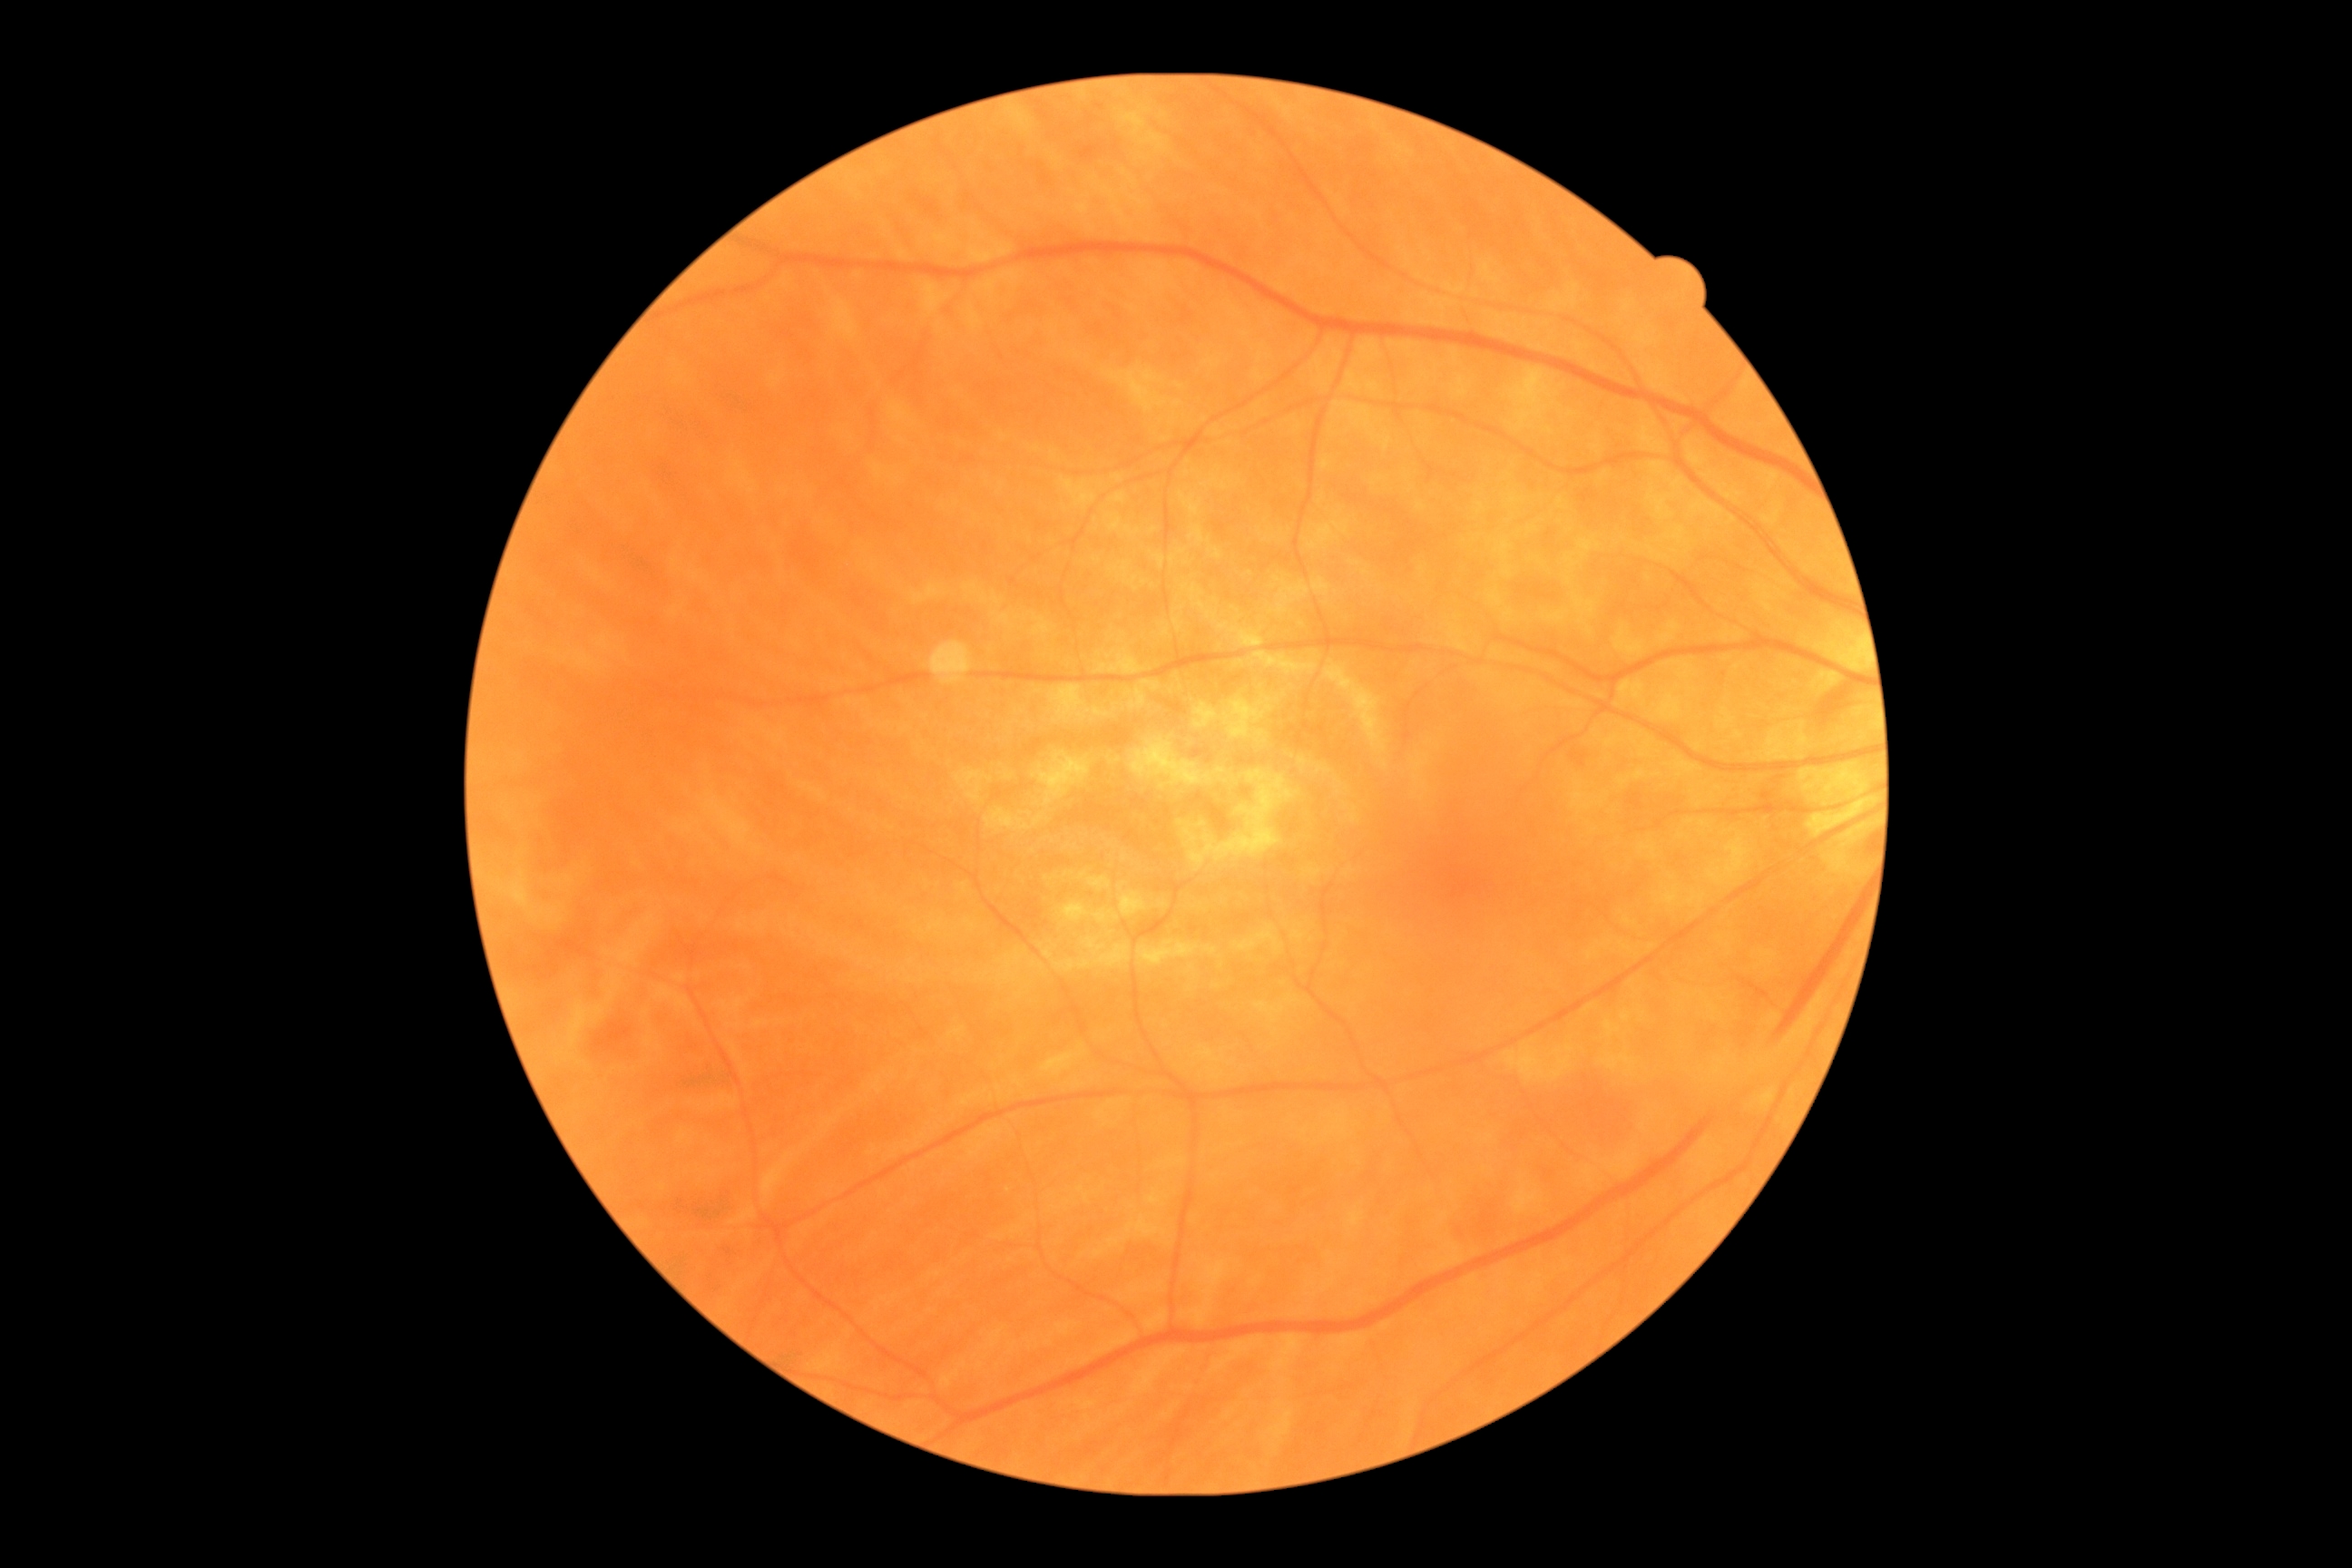
Diabetic retinopathy grade is 0 (no apparent retinopathy).